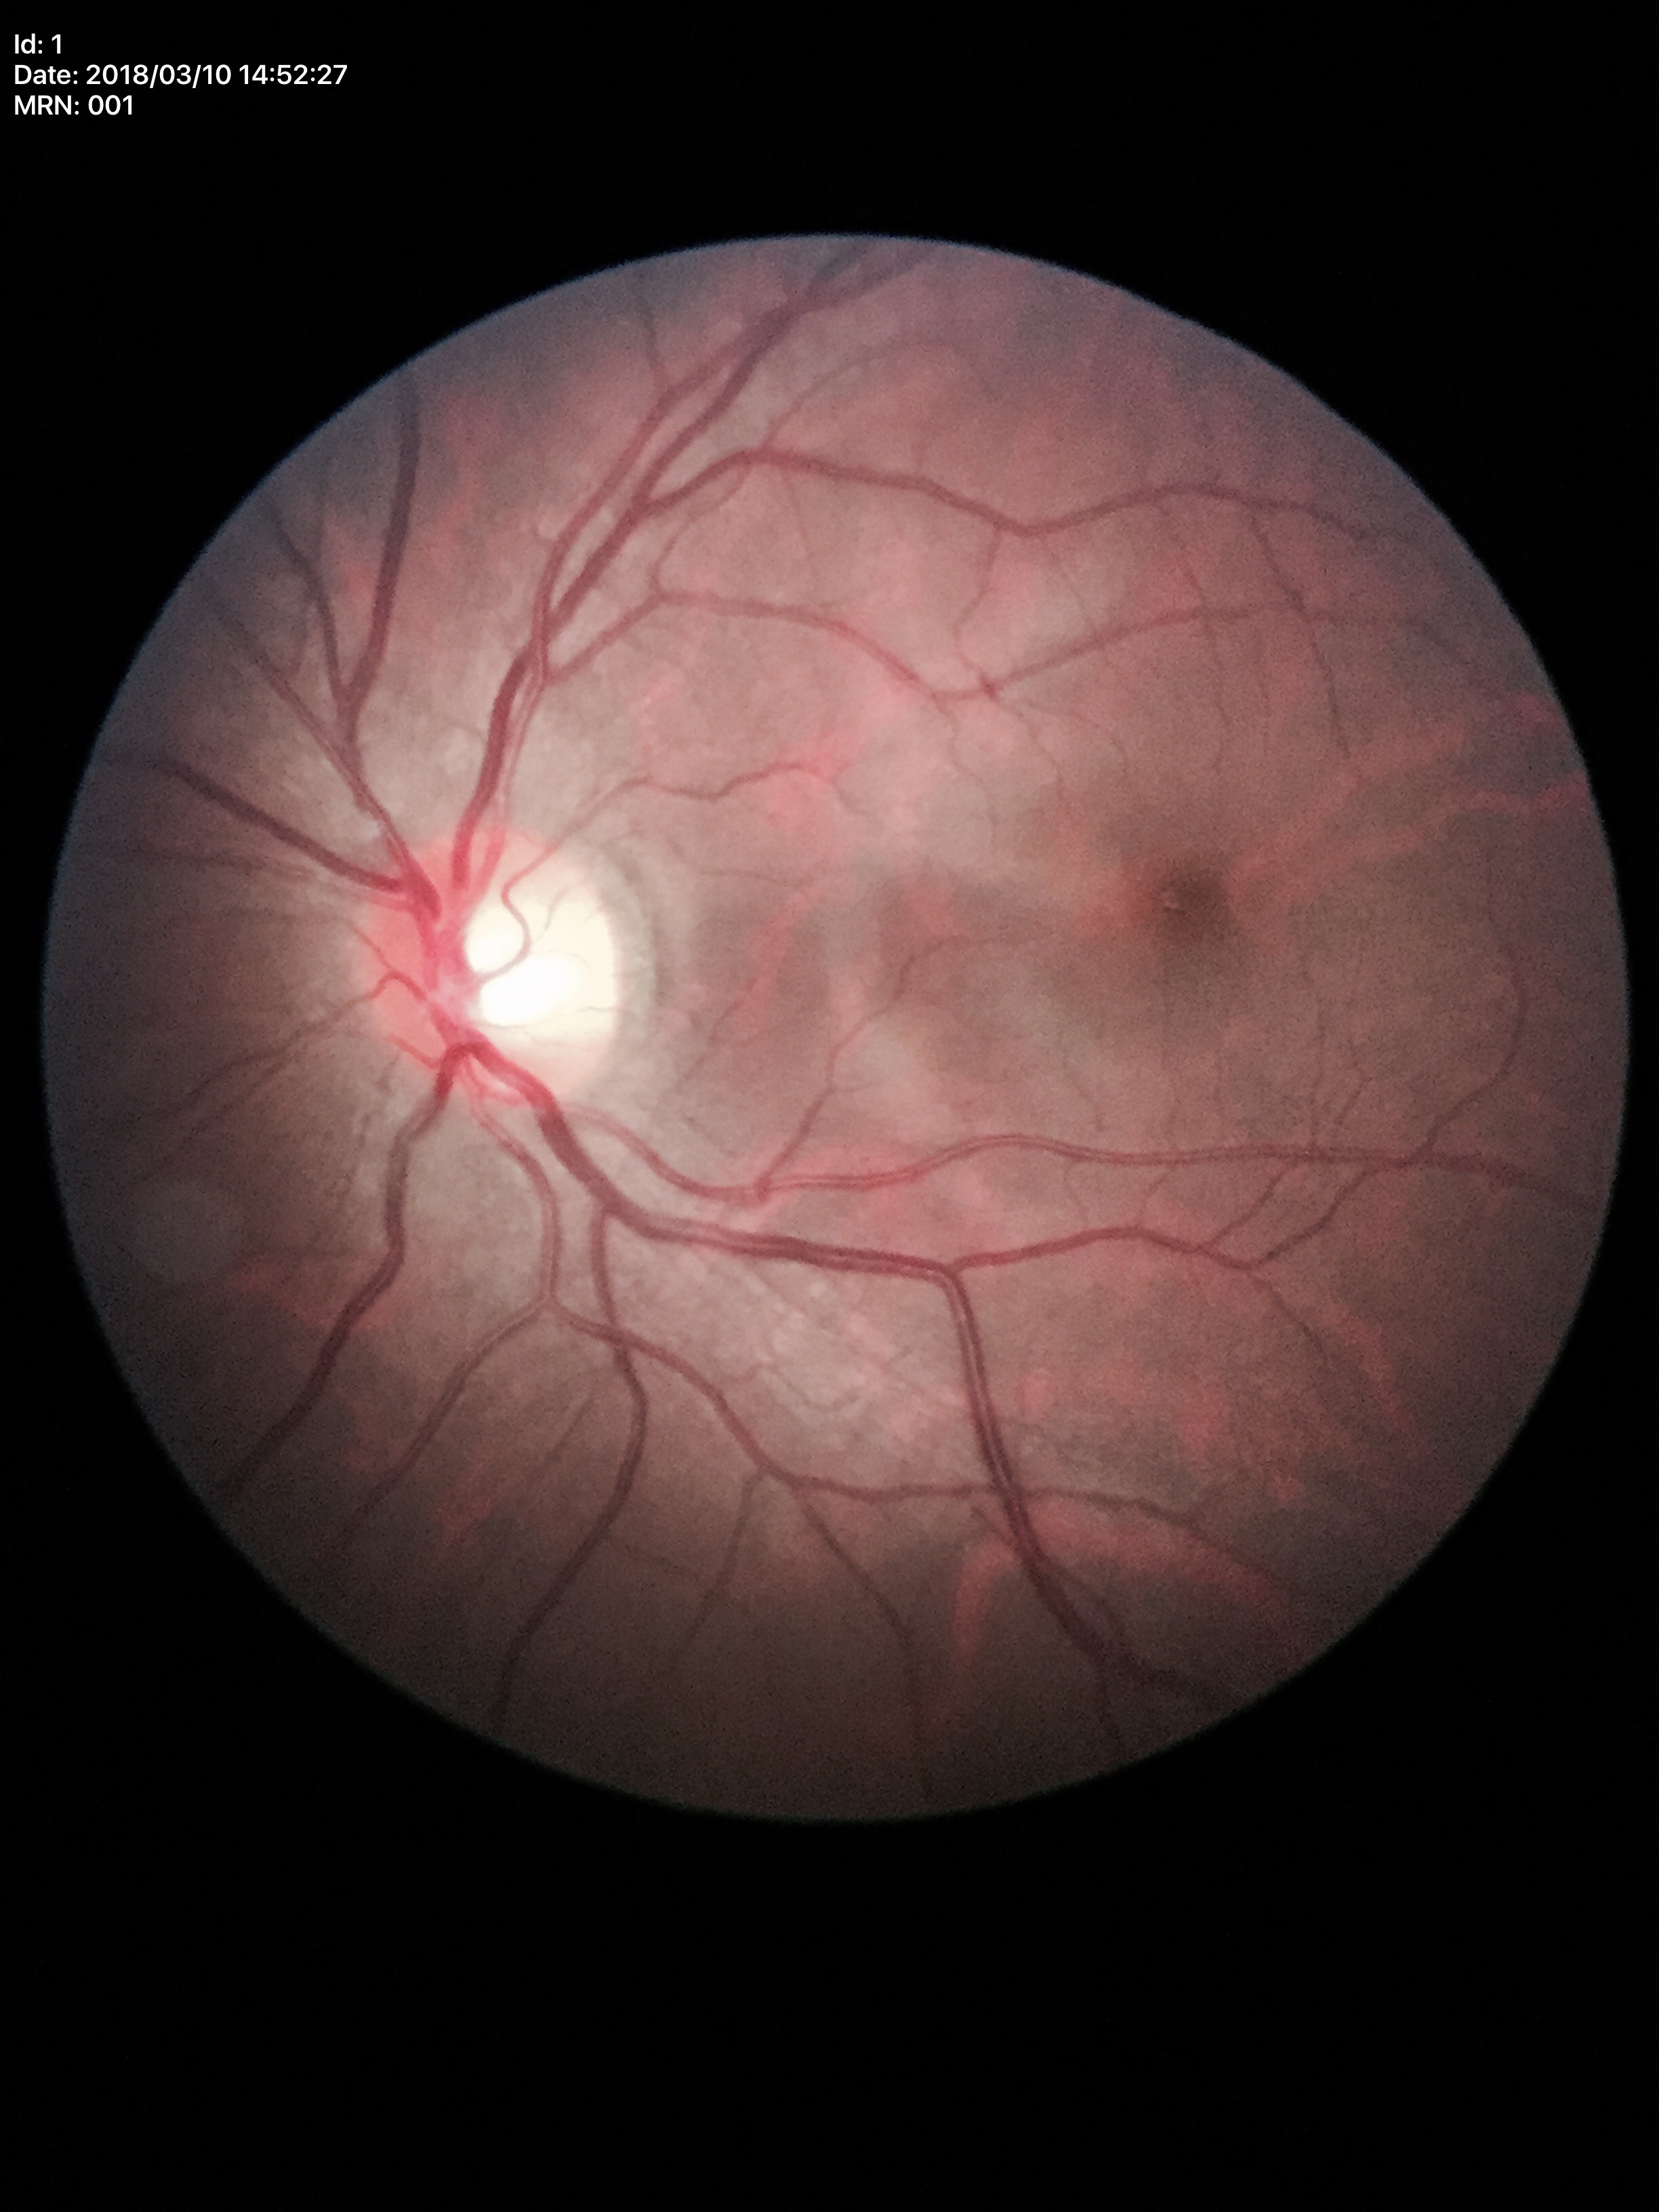 HCDR: 0.56.
Glaucoma suspect (3 of 5 graders flagged glaucoma suspect).
VCDR: 0.59.